2352 by 1568 pixels; FOV: 45 degrees; color fundus photograph.
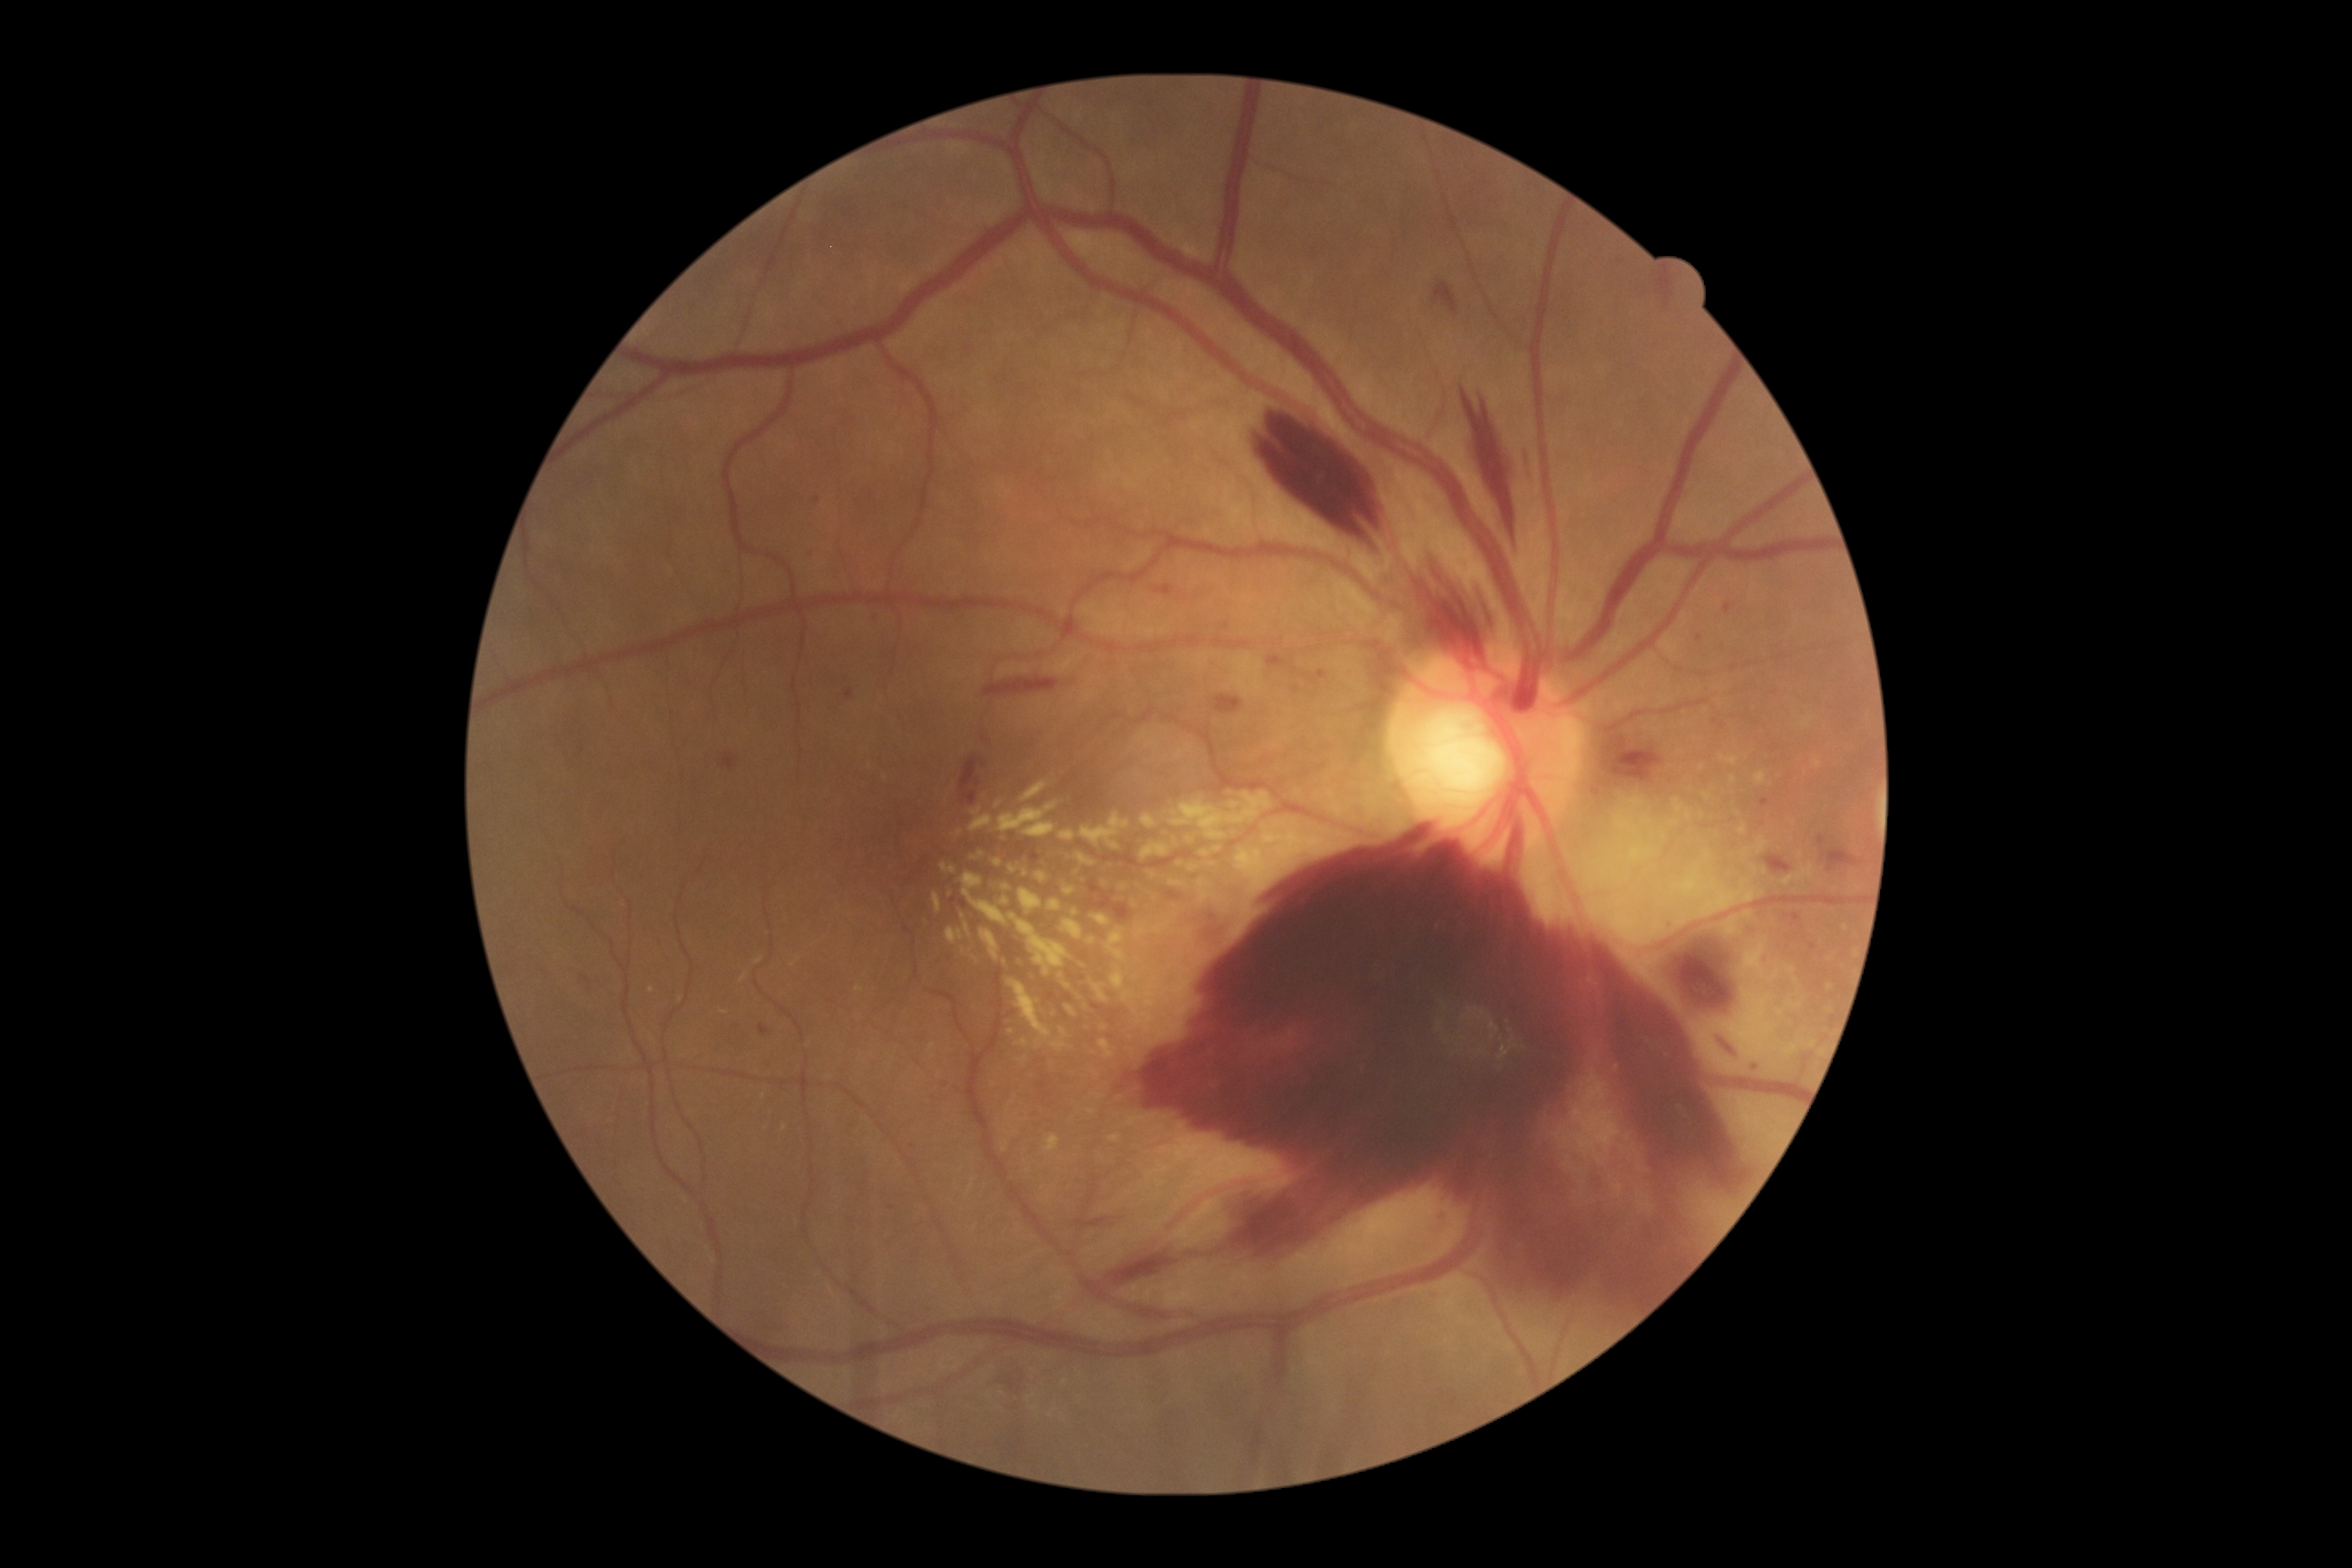 DR grade = 4.